DR severity per modified Davis staging:
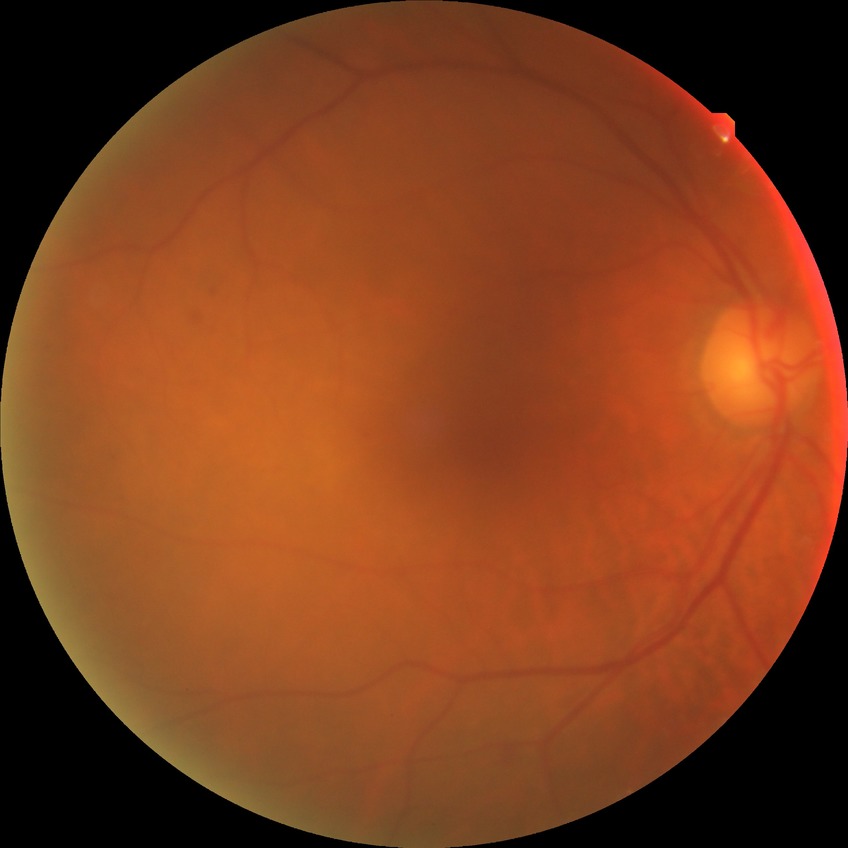 diabetic retinopathy (DR): SDR (simple diabetic retinopathy).